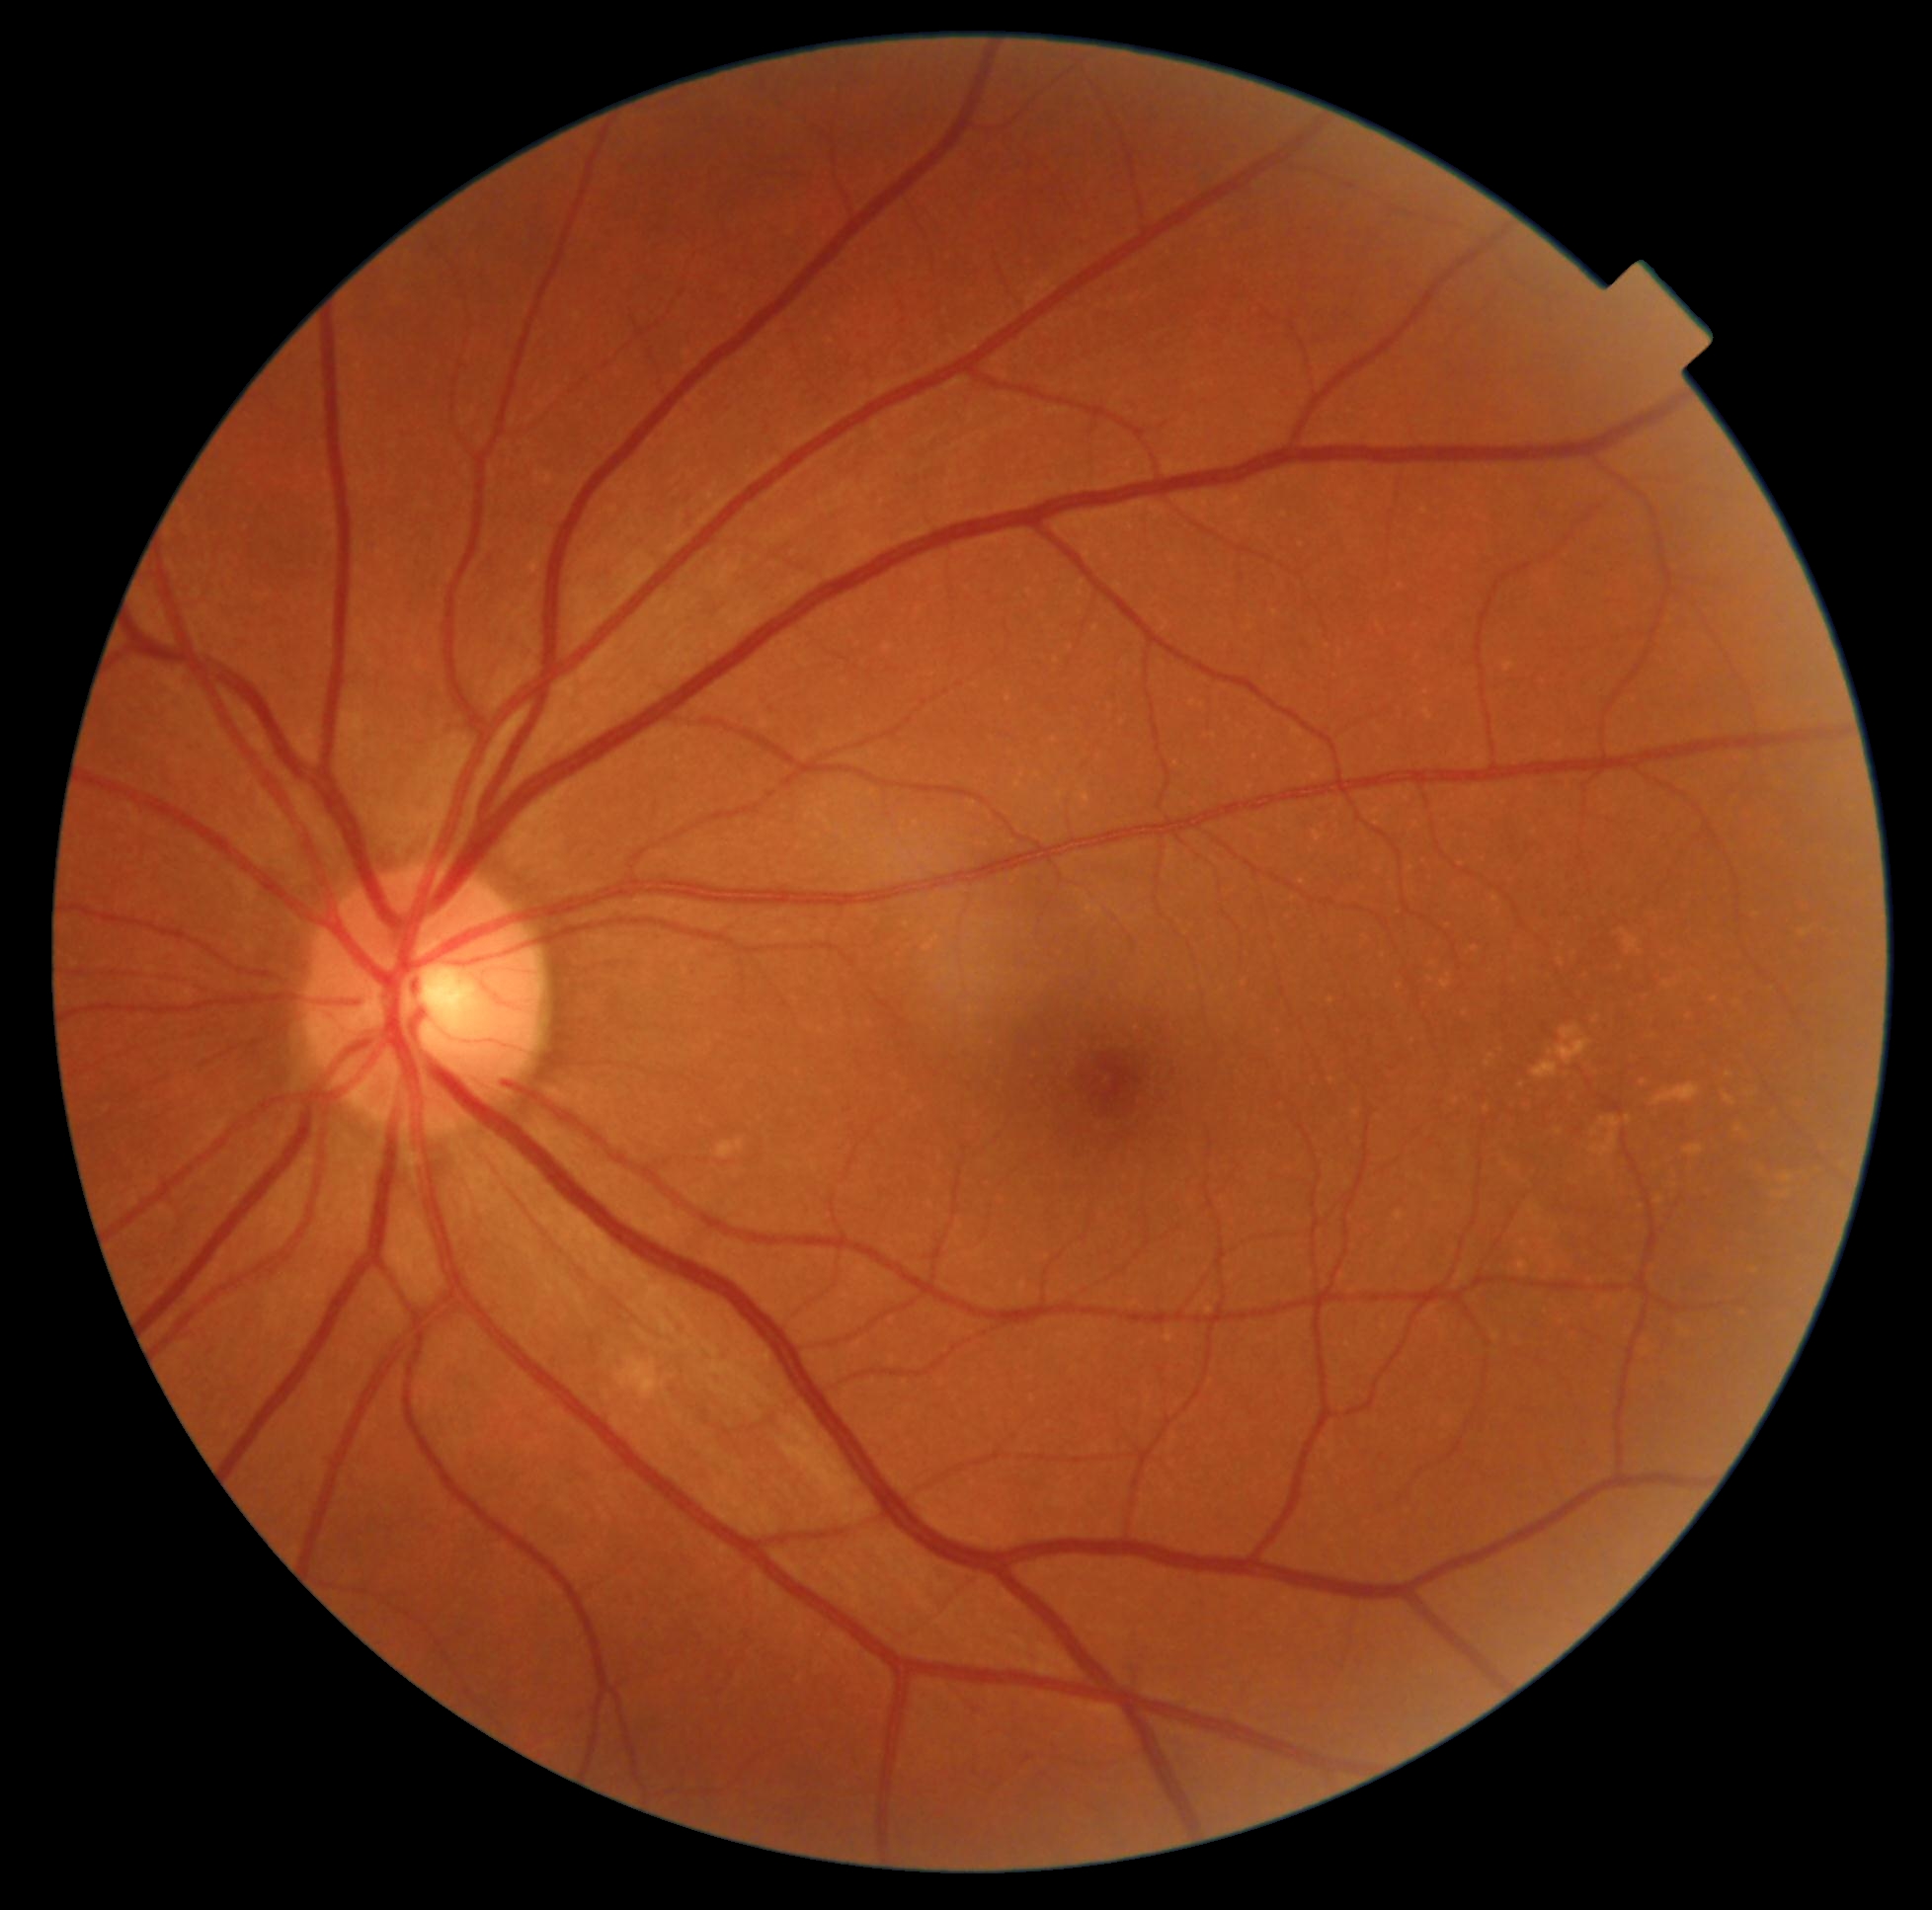 DR grade is no apparent diabetic retinopathy (0).